Pediatric wide-field fundus photograph; captured with the Natus RetCam Envision (130° field of view); 1440 x 1080 pixels.
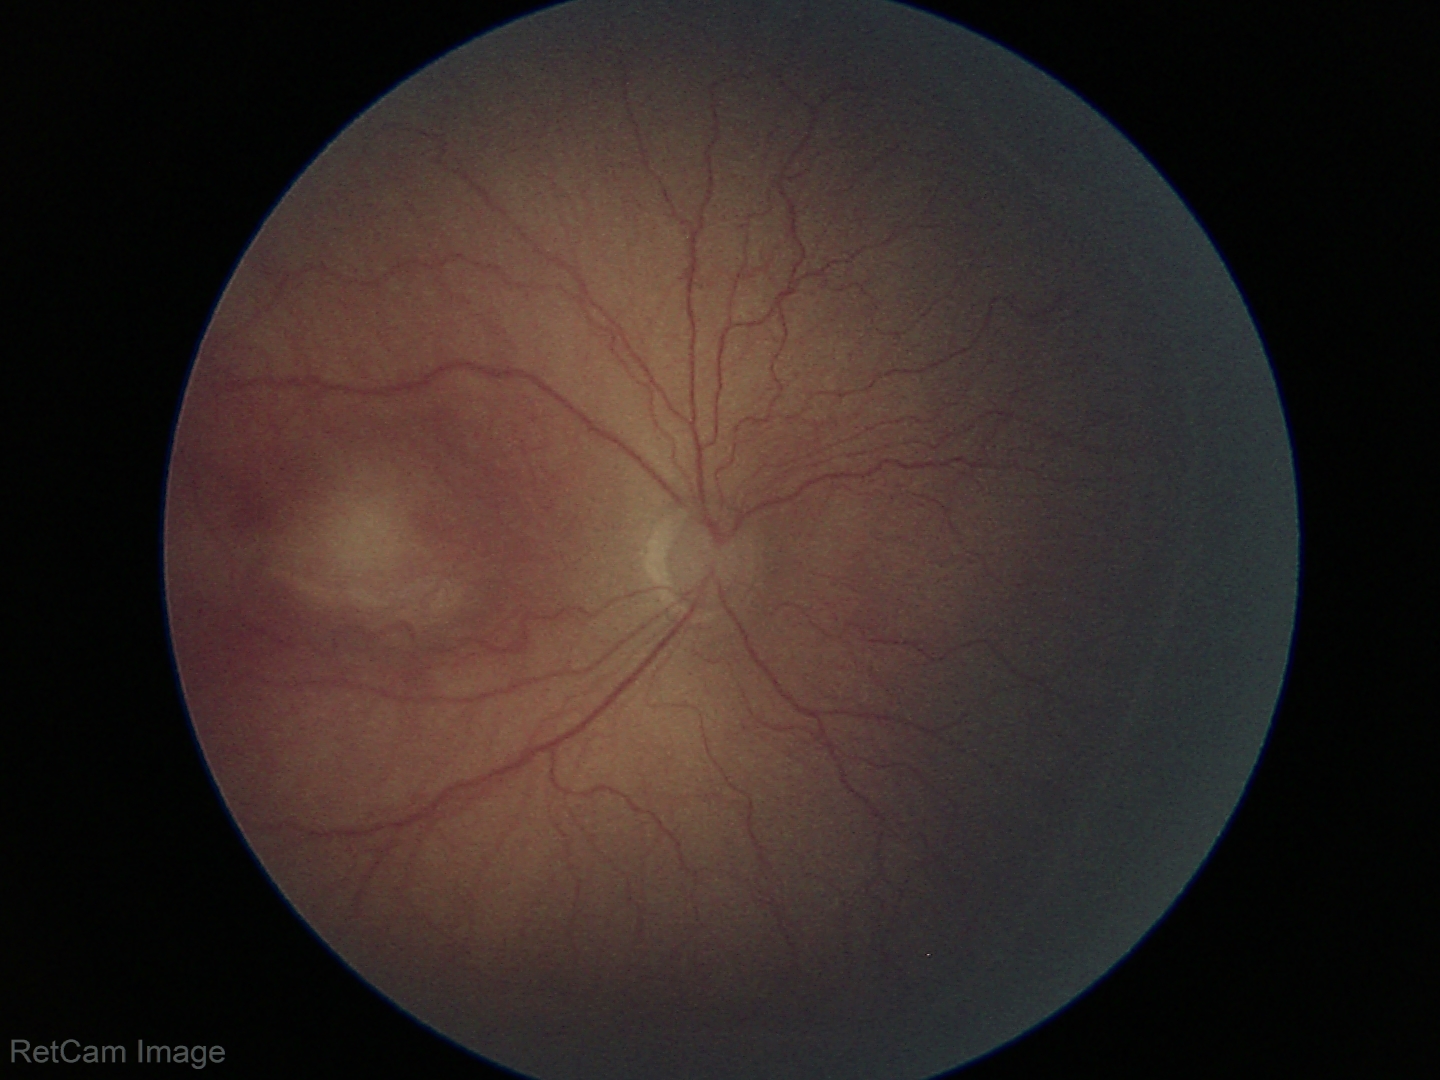
Series diagnosed as retinopathy of prematurity (ROP) stage 2 — ridge with height and width at the demarcation line.
Without plus disease.